Pediatric retinal photograph (wide-field); 1440x1080; Natus RetCam Envision, 130° FOV:
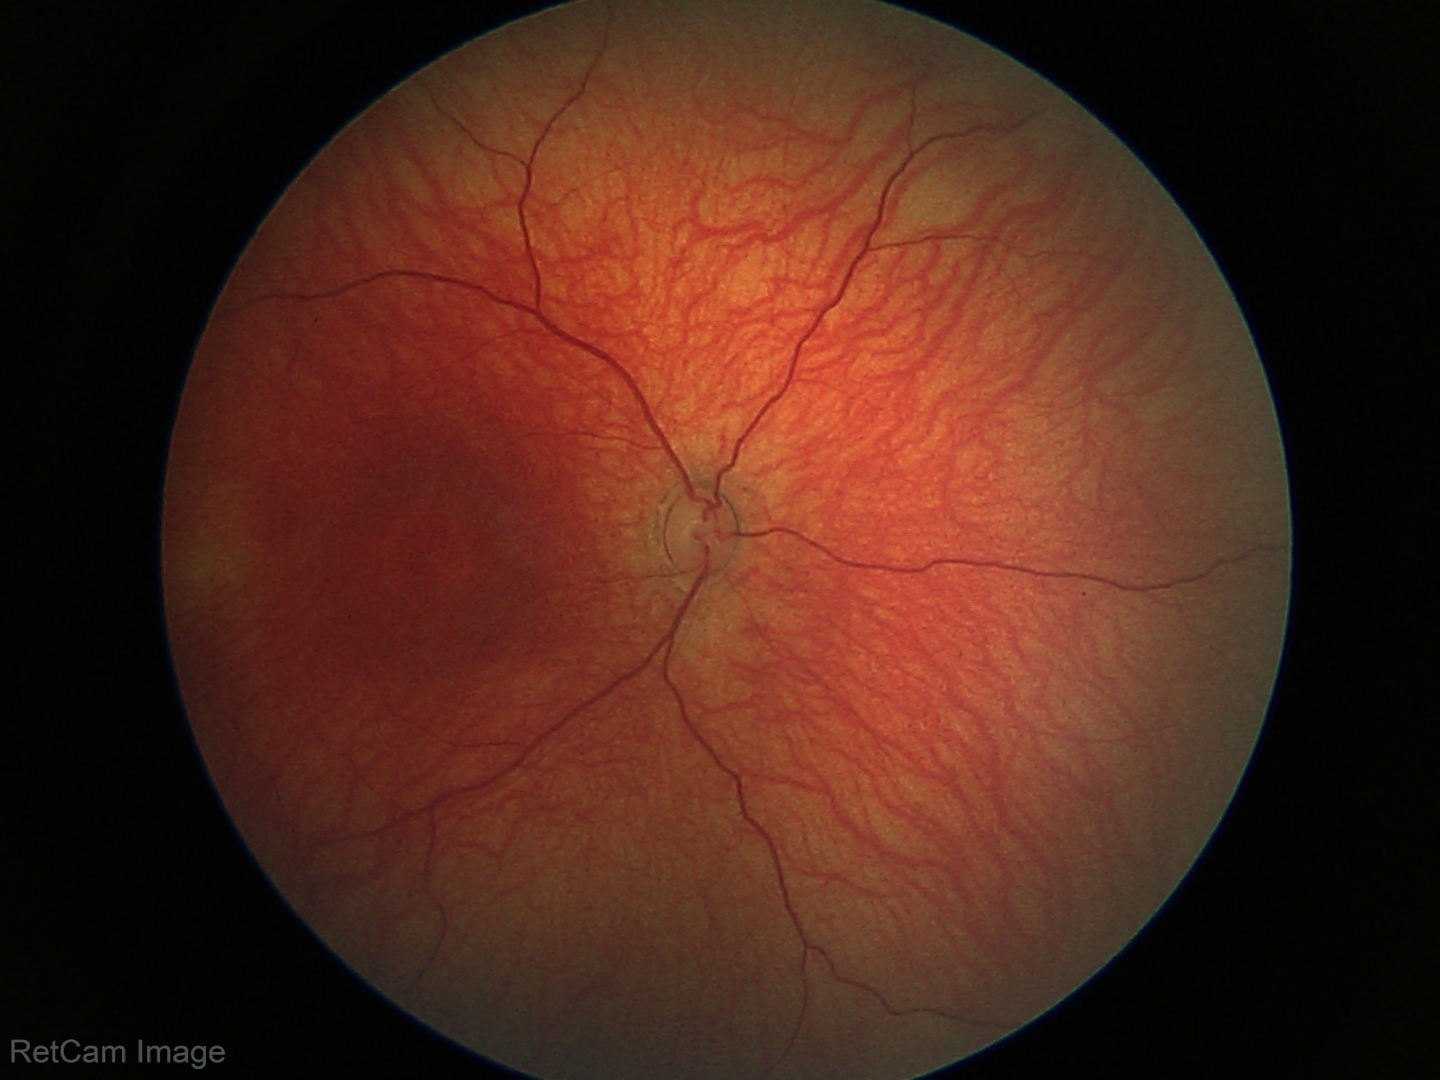 Physiological retinal appearance for postconceptual age.